Posterior pole field covering the optic disc and macula:
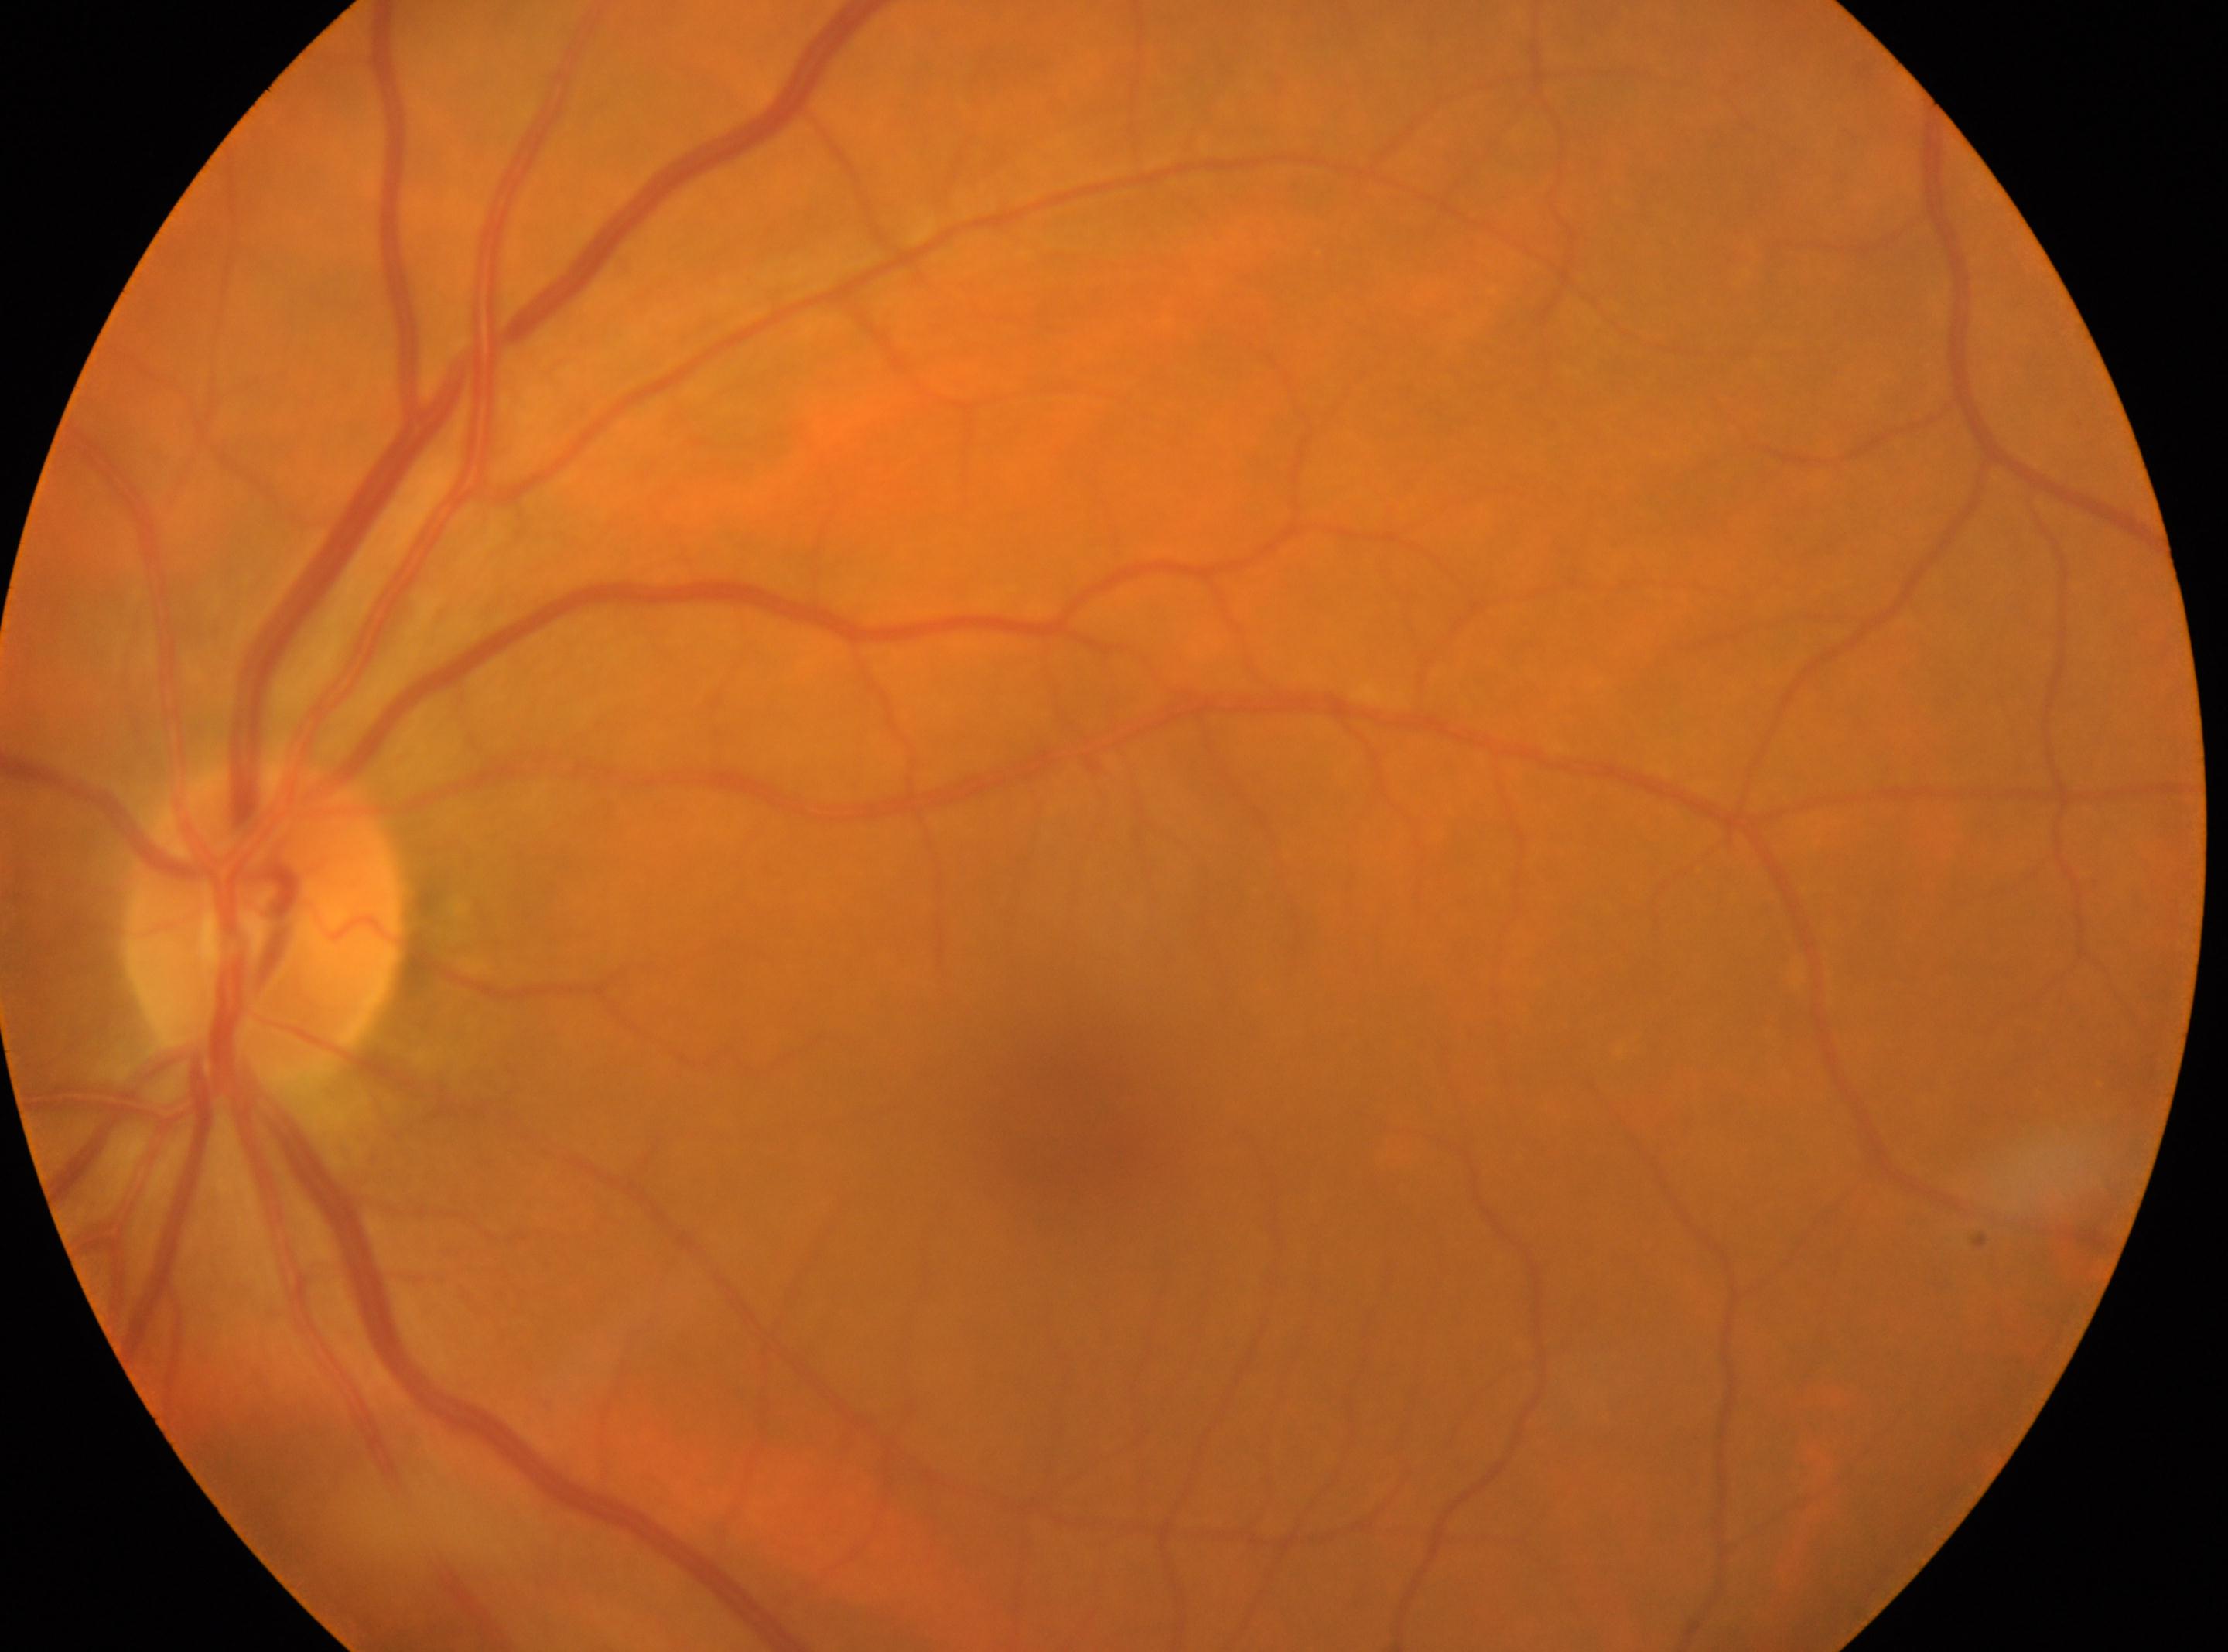 | field | value |
|---|---|
| the fovea | (x=1060, y=1128) |
| retinopathy | grade 0 (no apparent retinopathy) |
| optic disc | (x=265, y=925) |
| laterality | left eye |
| DR impression | No diabetic retinal disease findings |